1240x1240 · pediatric retinal photograph (wide-field).
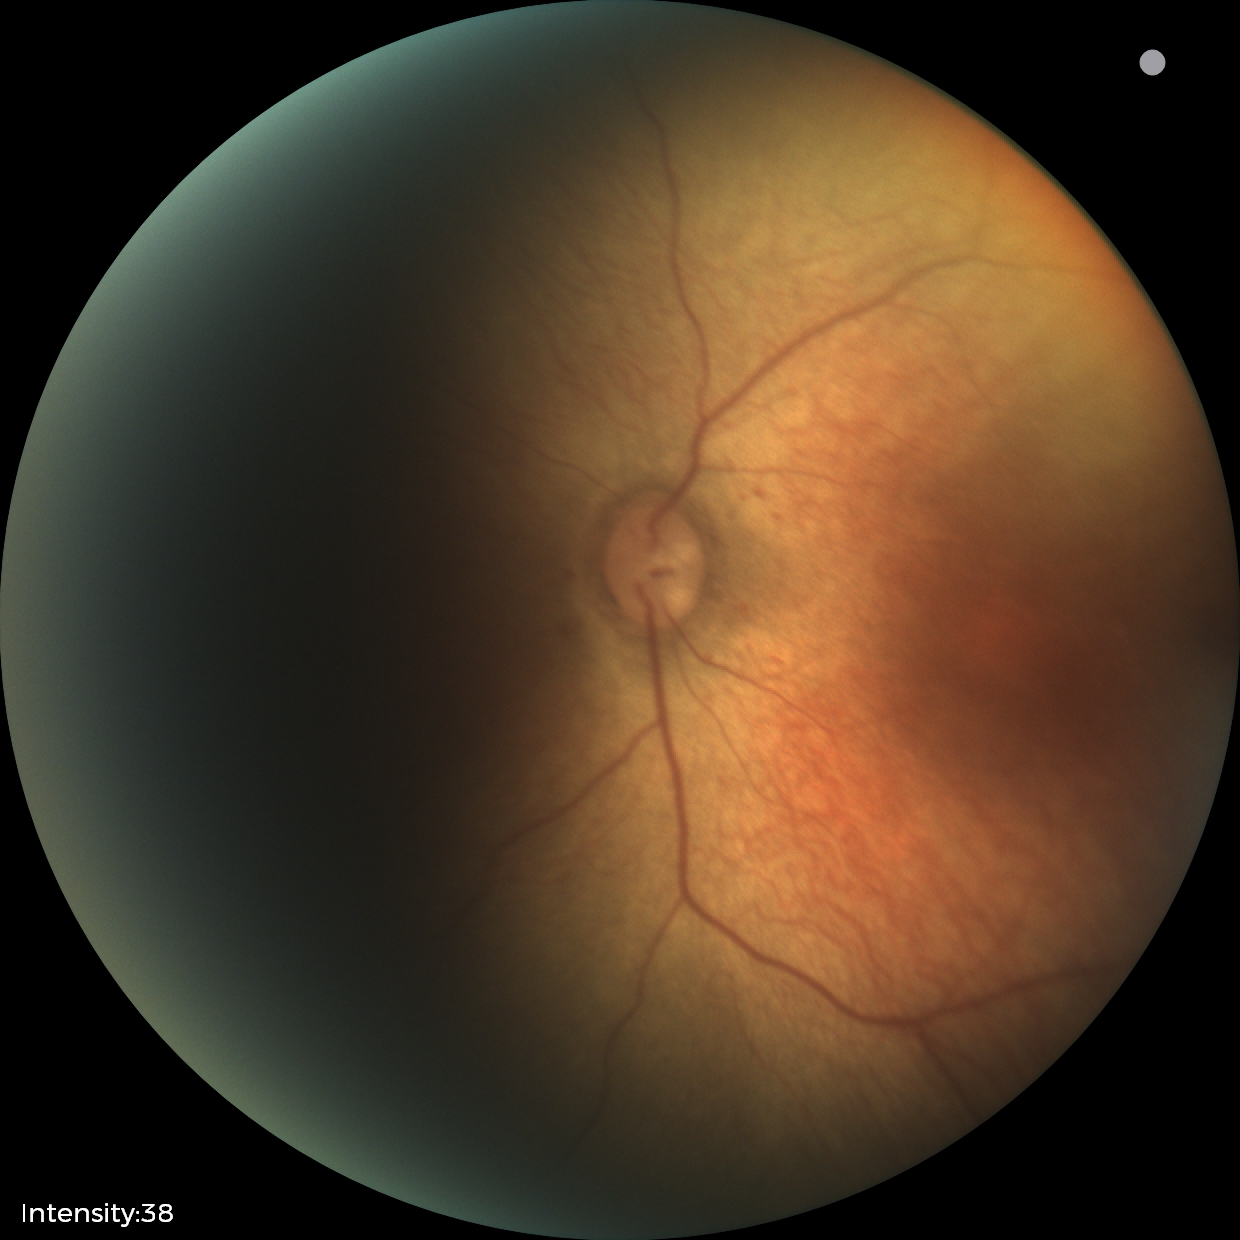

Assessment: physiological finding.